NIDEK AFC-230 fundus camera, 848x848px, retinal fundus photograph.
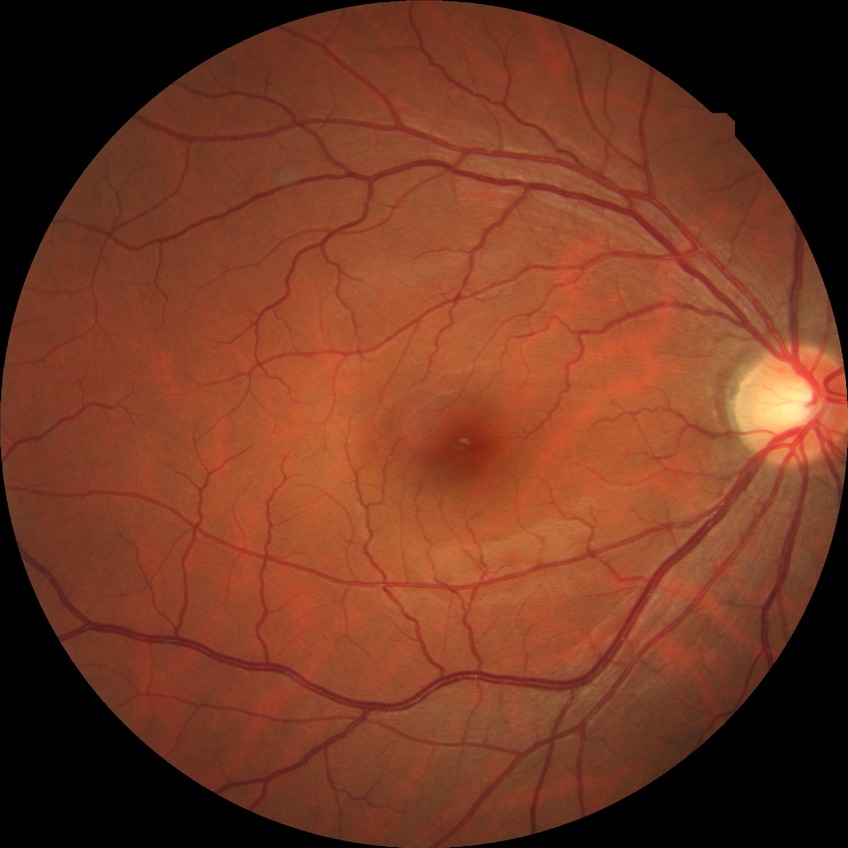
- Davis DR grade: NDR